CFP. Image size 2089x1764.
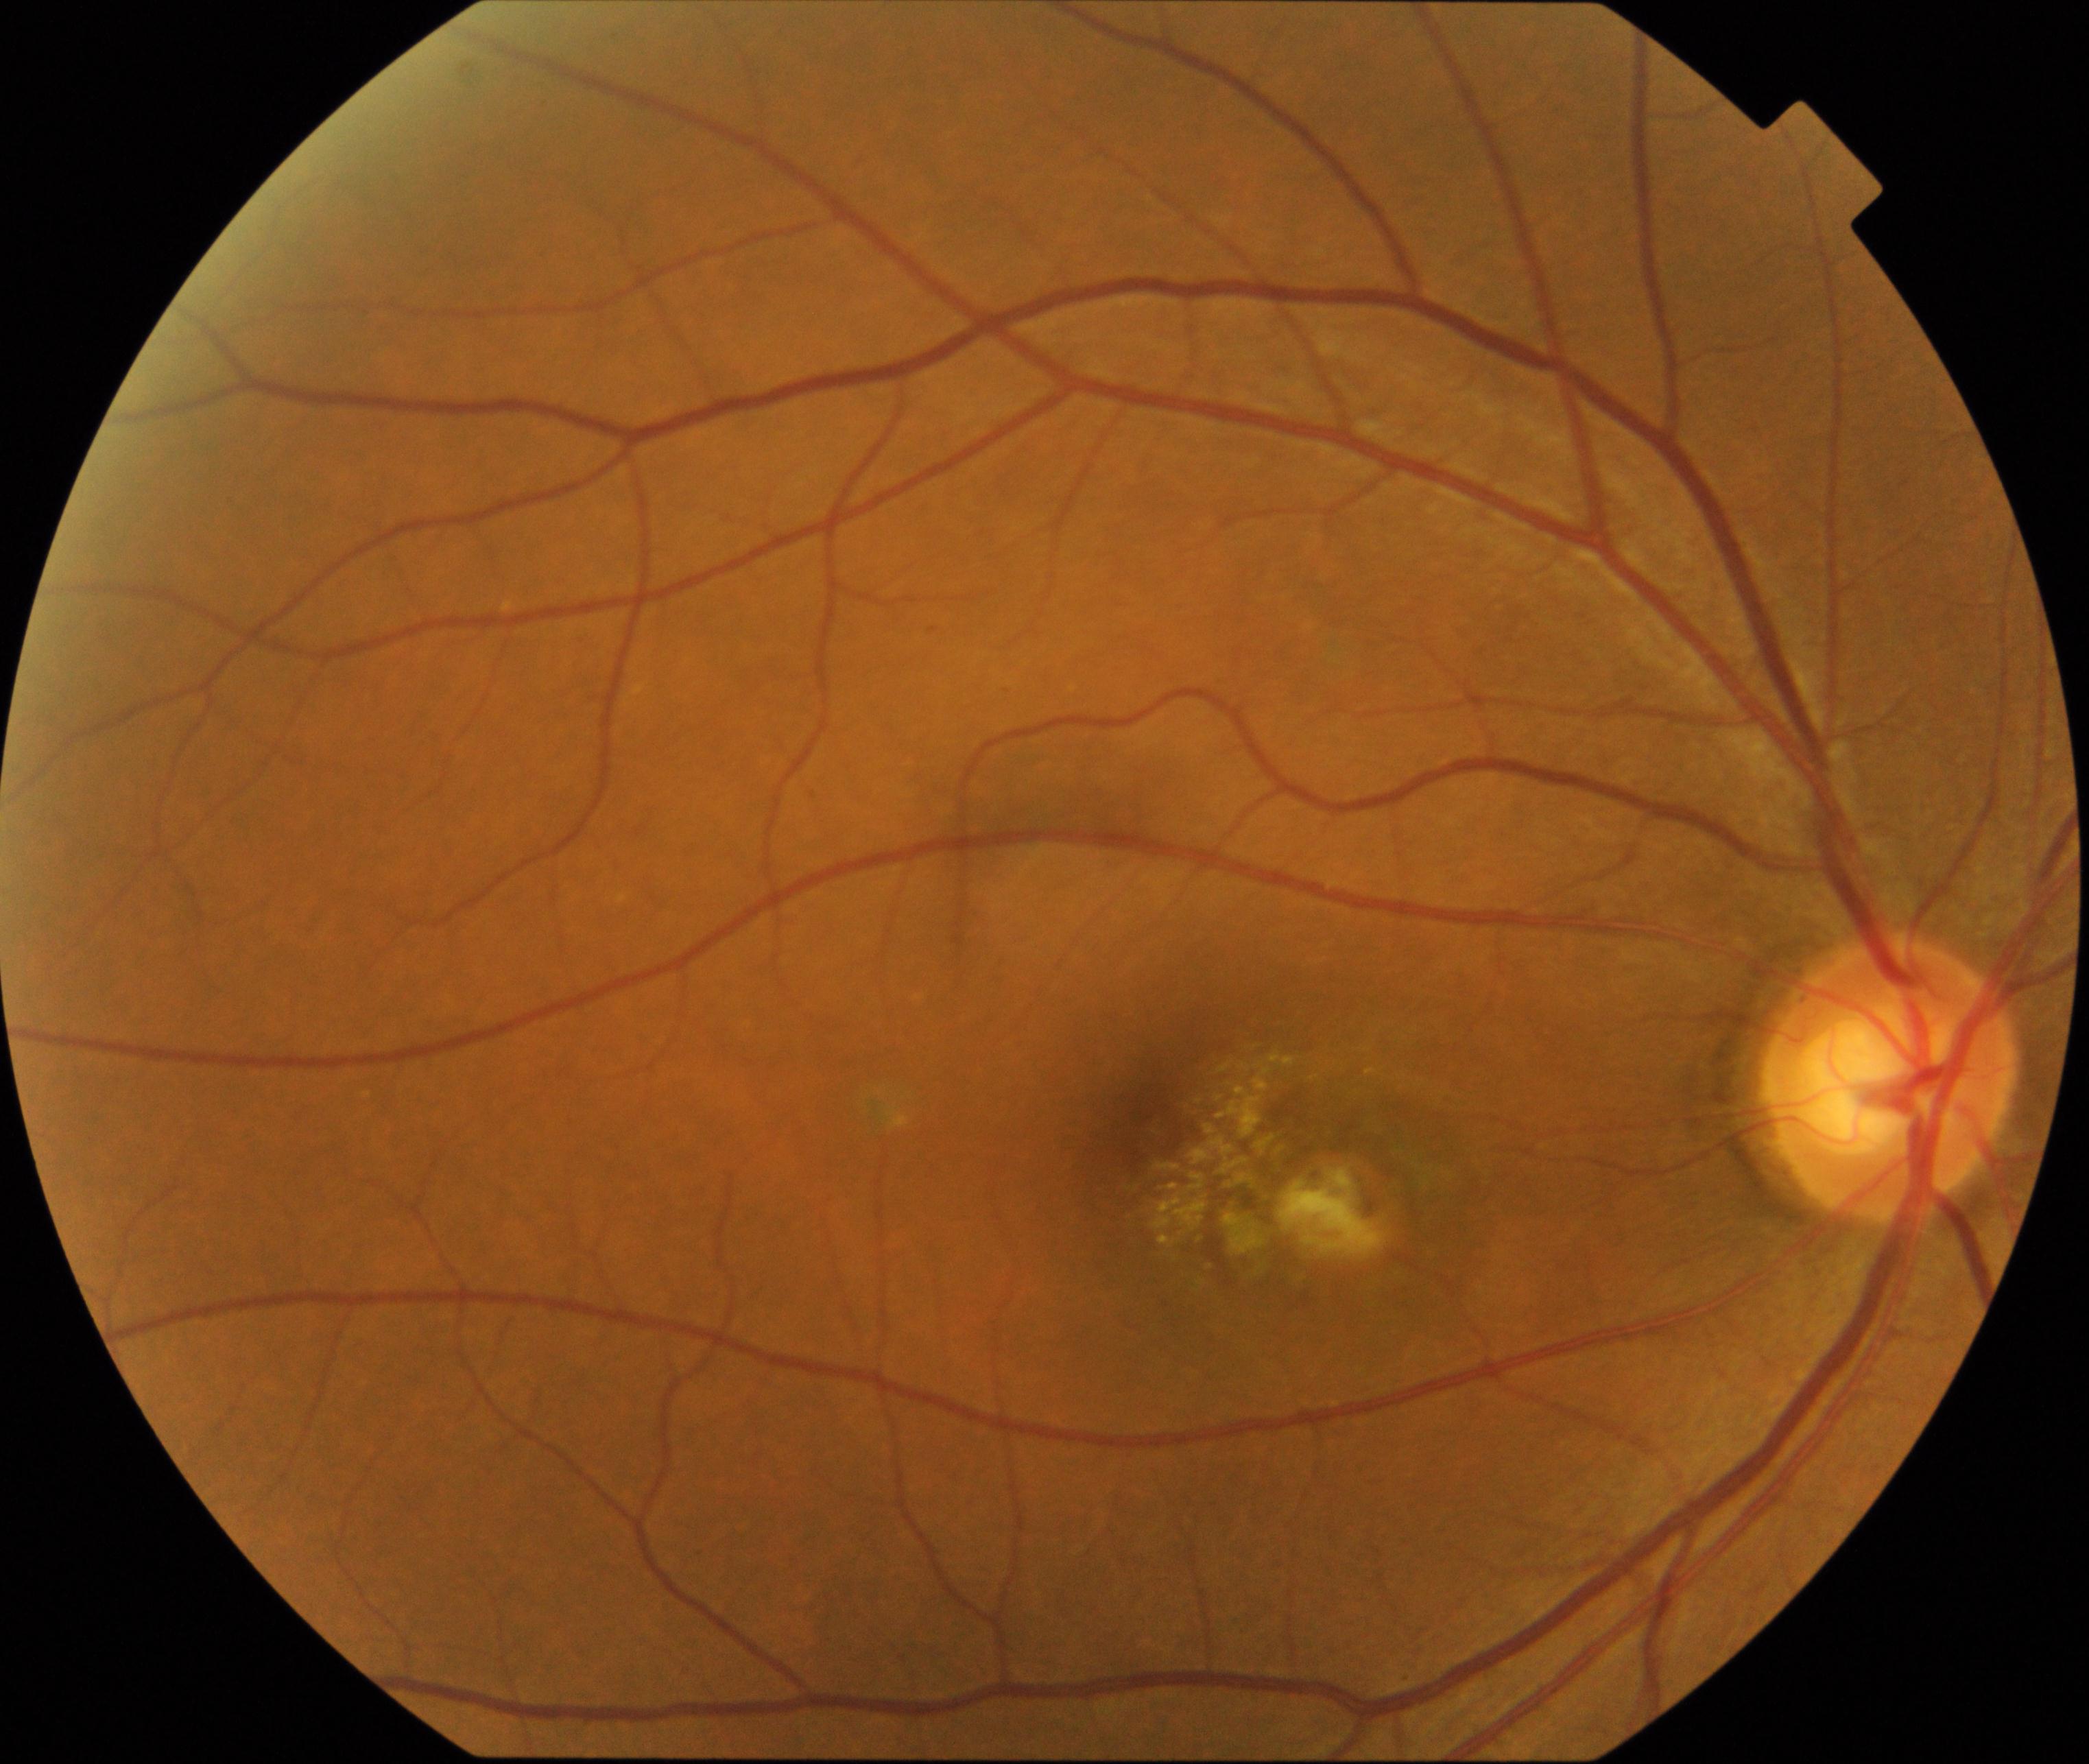 There is evidence of maculopathy.